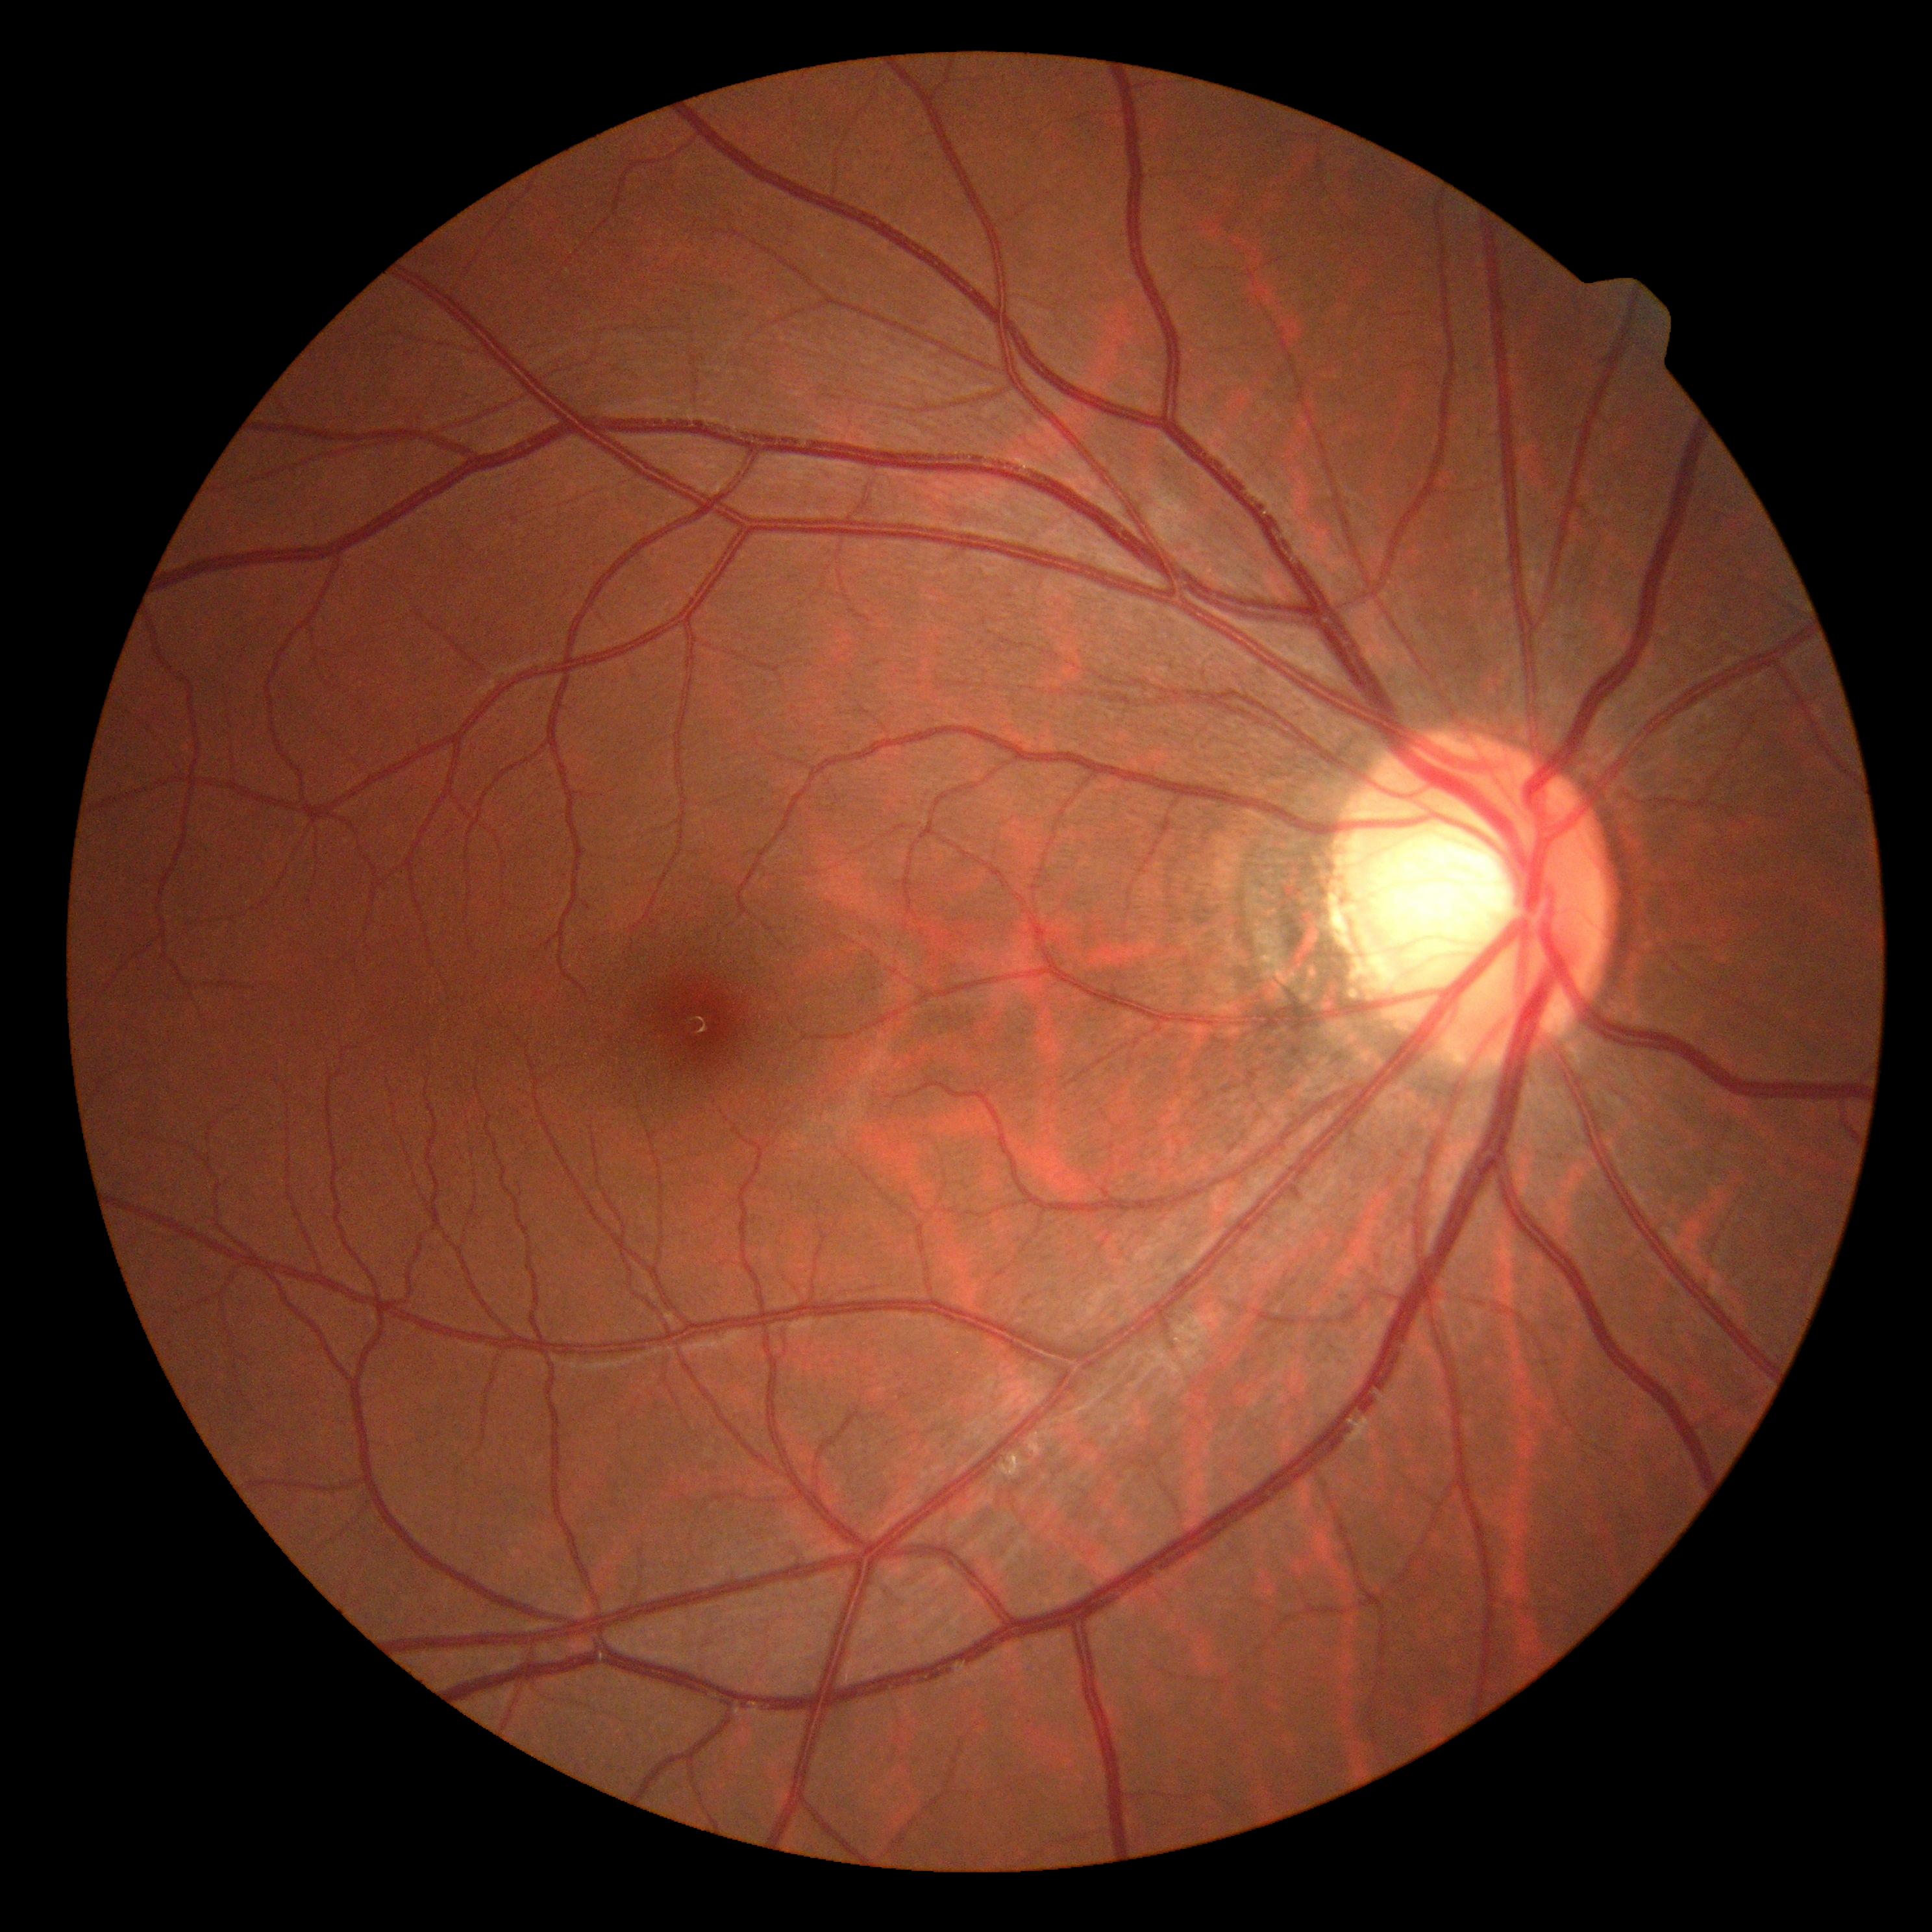

Annotations:
* DR impression: no apparent DR
* DR severity: 0 — no visible signs of diabetic retinopathy